Modified Davis grading · camera: NIDEK AFC-230 · image size 848x848
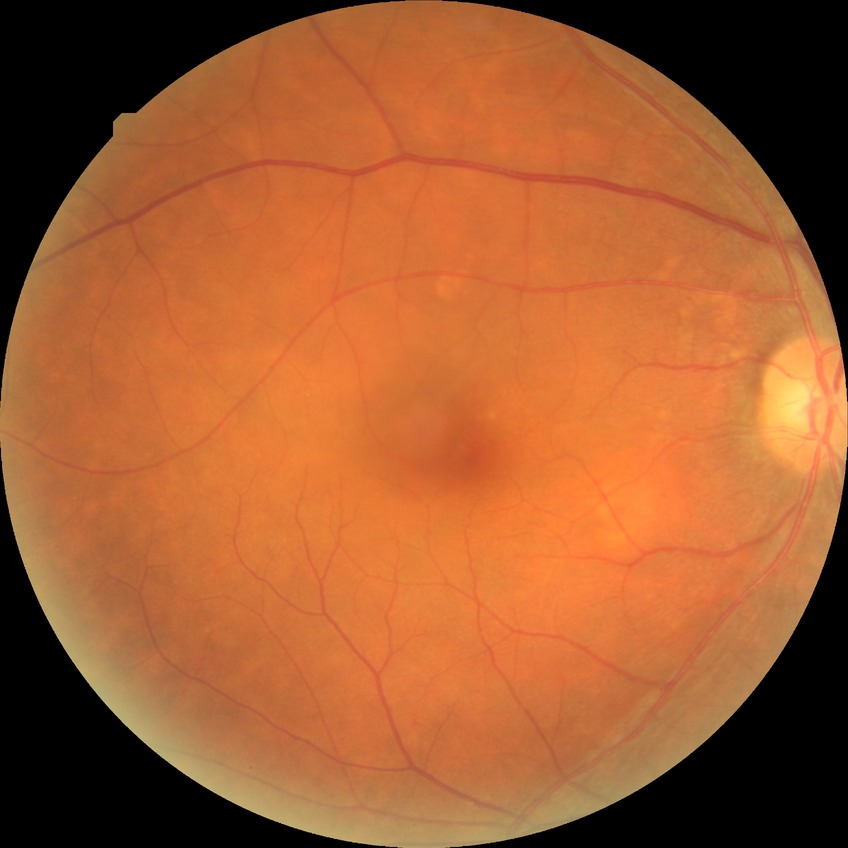
Diabetic retinopathy (DR) is SDR (simple diabetic retinopathy).